Wide-field contact fundus photograph of an infant · 1240x1240: 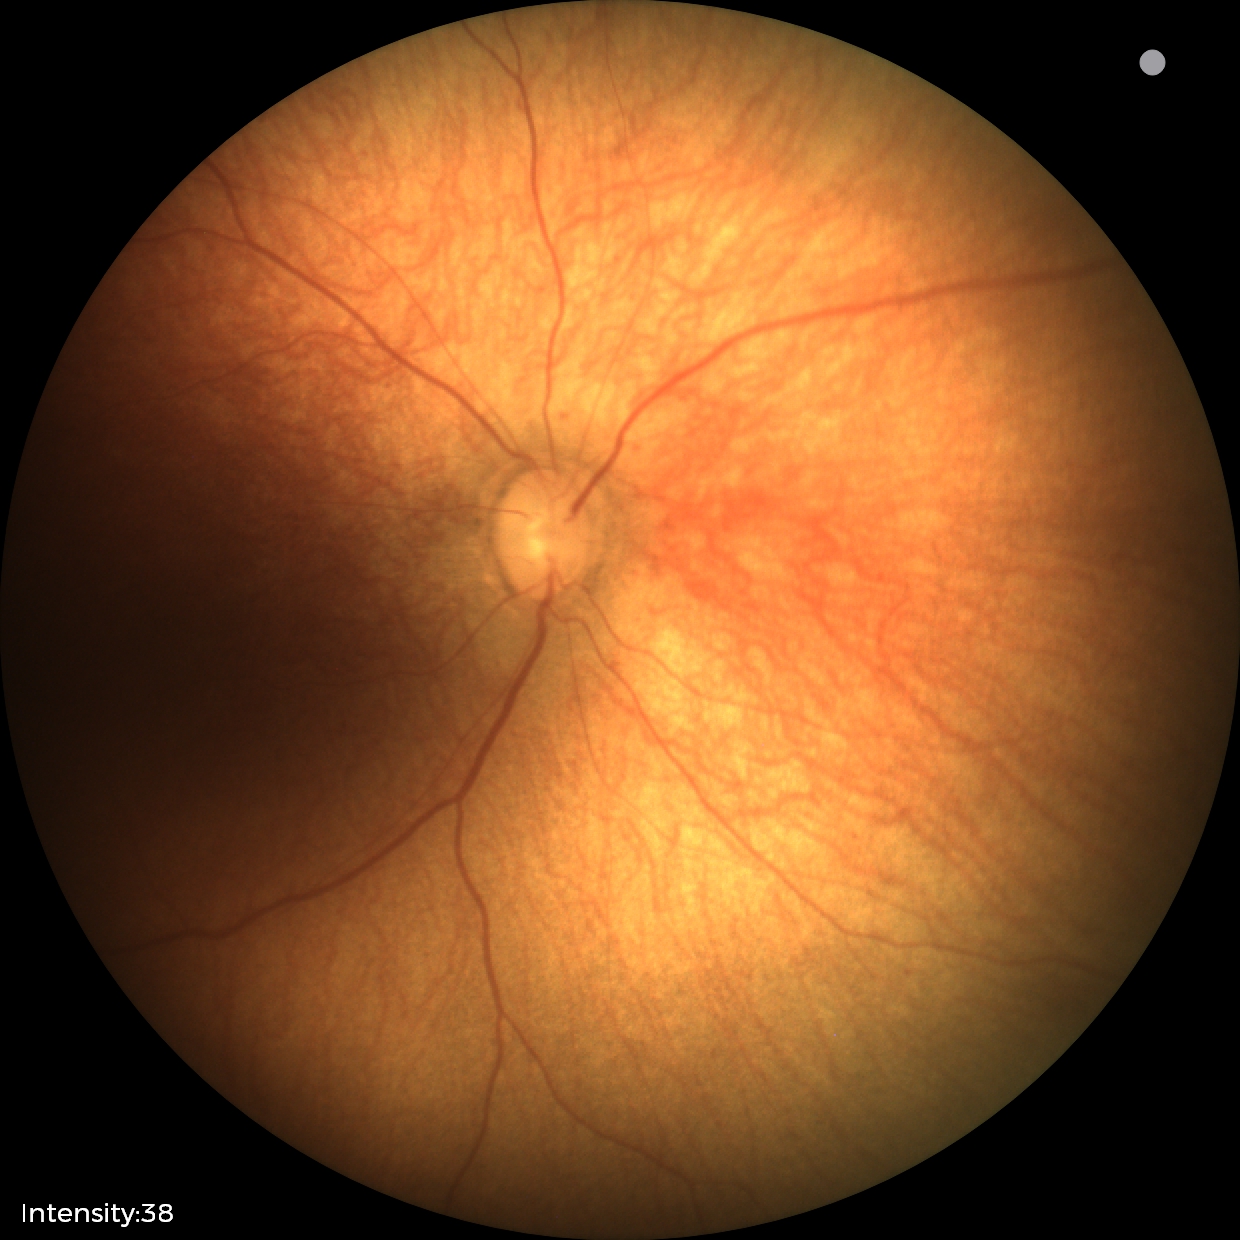 Normal screening examination.